Non-mydriatic; 240x240
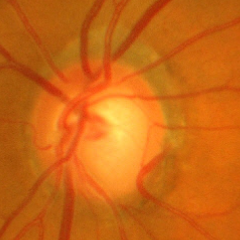

Fundus appearance consistent with advanced-stage glaucoma. Diagnostic criteria: near-total cupping of the optic nerve head, with or without severe visual field loss within the central 10 degrees of fixation.